RetCam wide-field infant fundus image · 130° field of view (Clarity RetCam 3)
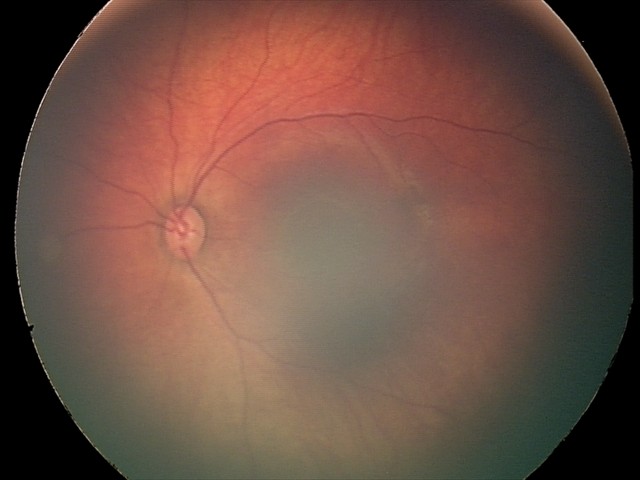
Assessment: retinal hemorrhages.